45° FOV:
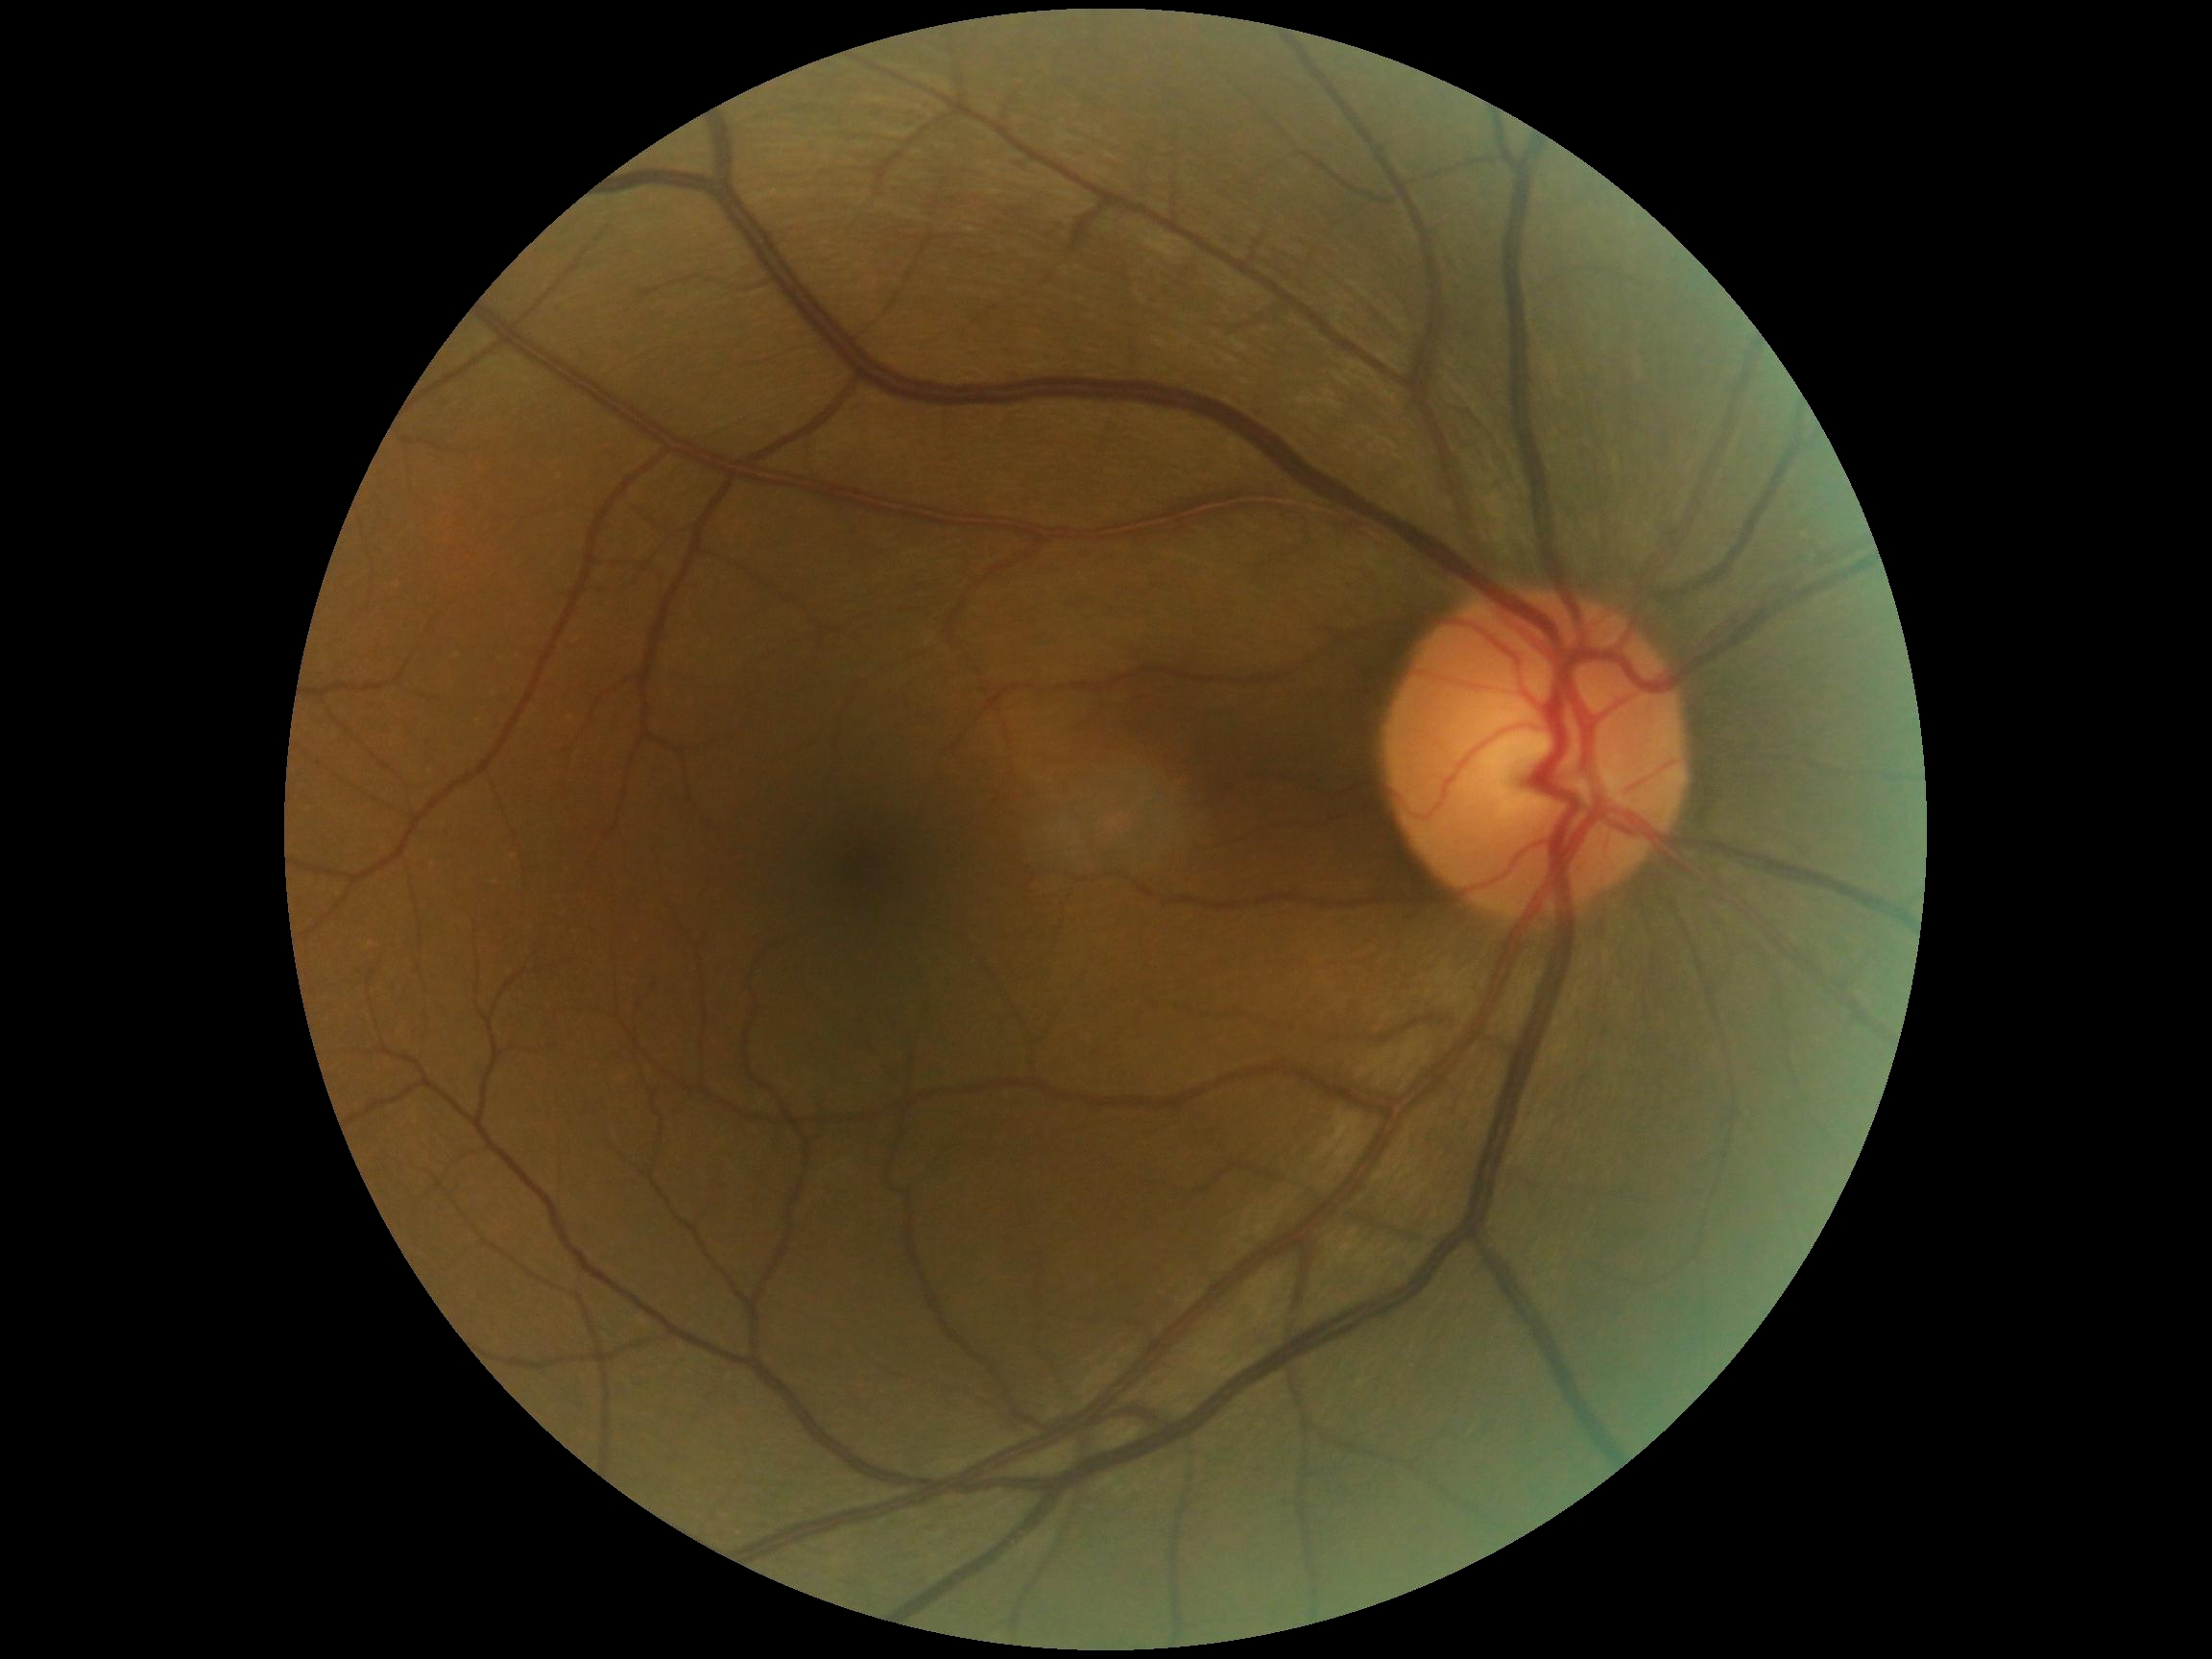
Diabetic retinopathy (DR) is grade 0 (no apparent retinopathy).